73 years old; optic disc-centered; gender: F; 30-degree field of view
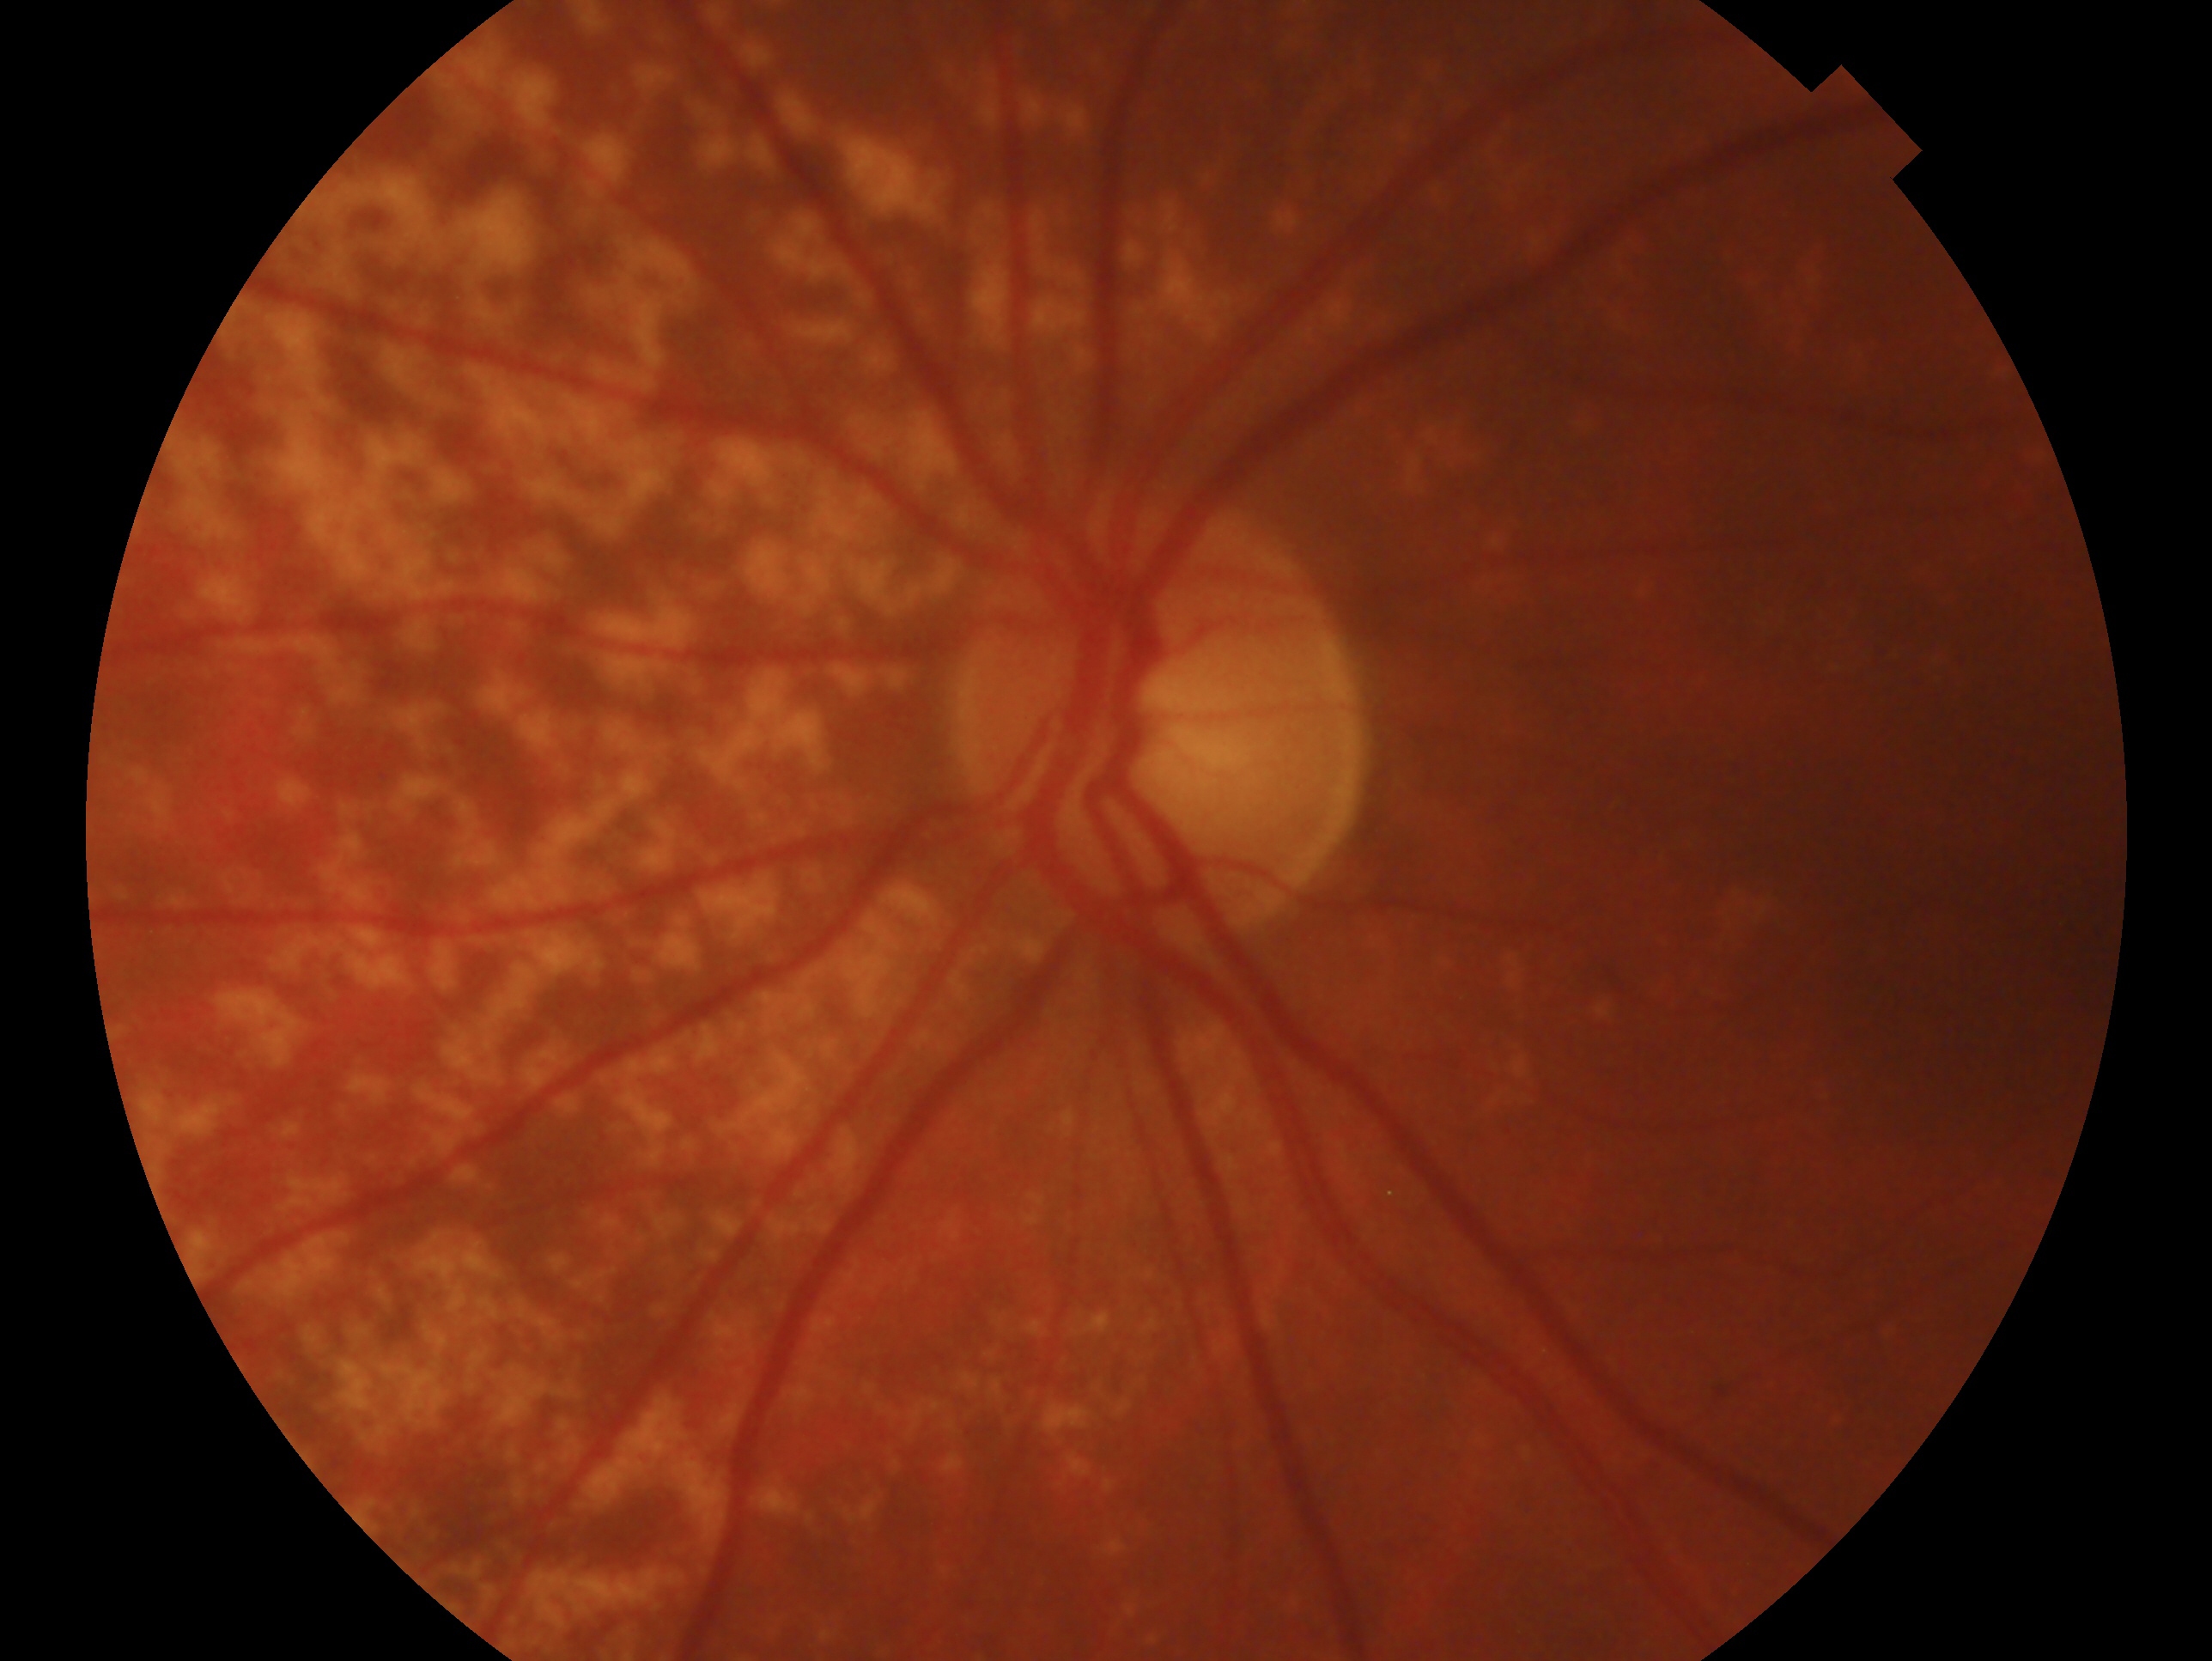
This is the OS. Clinical classification — negative for glaucoma.